CFP. 2212 x 1659 pixels. 45-degree field of view — 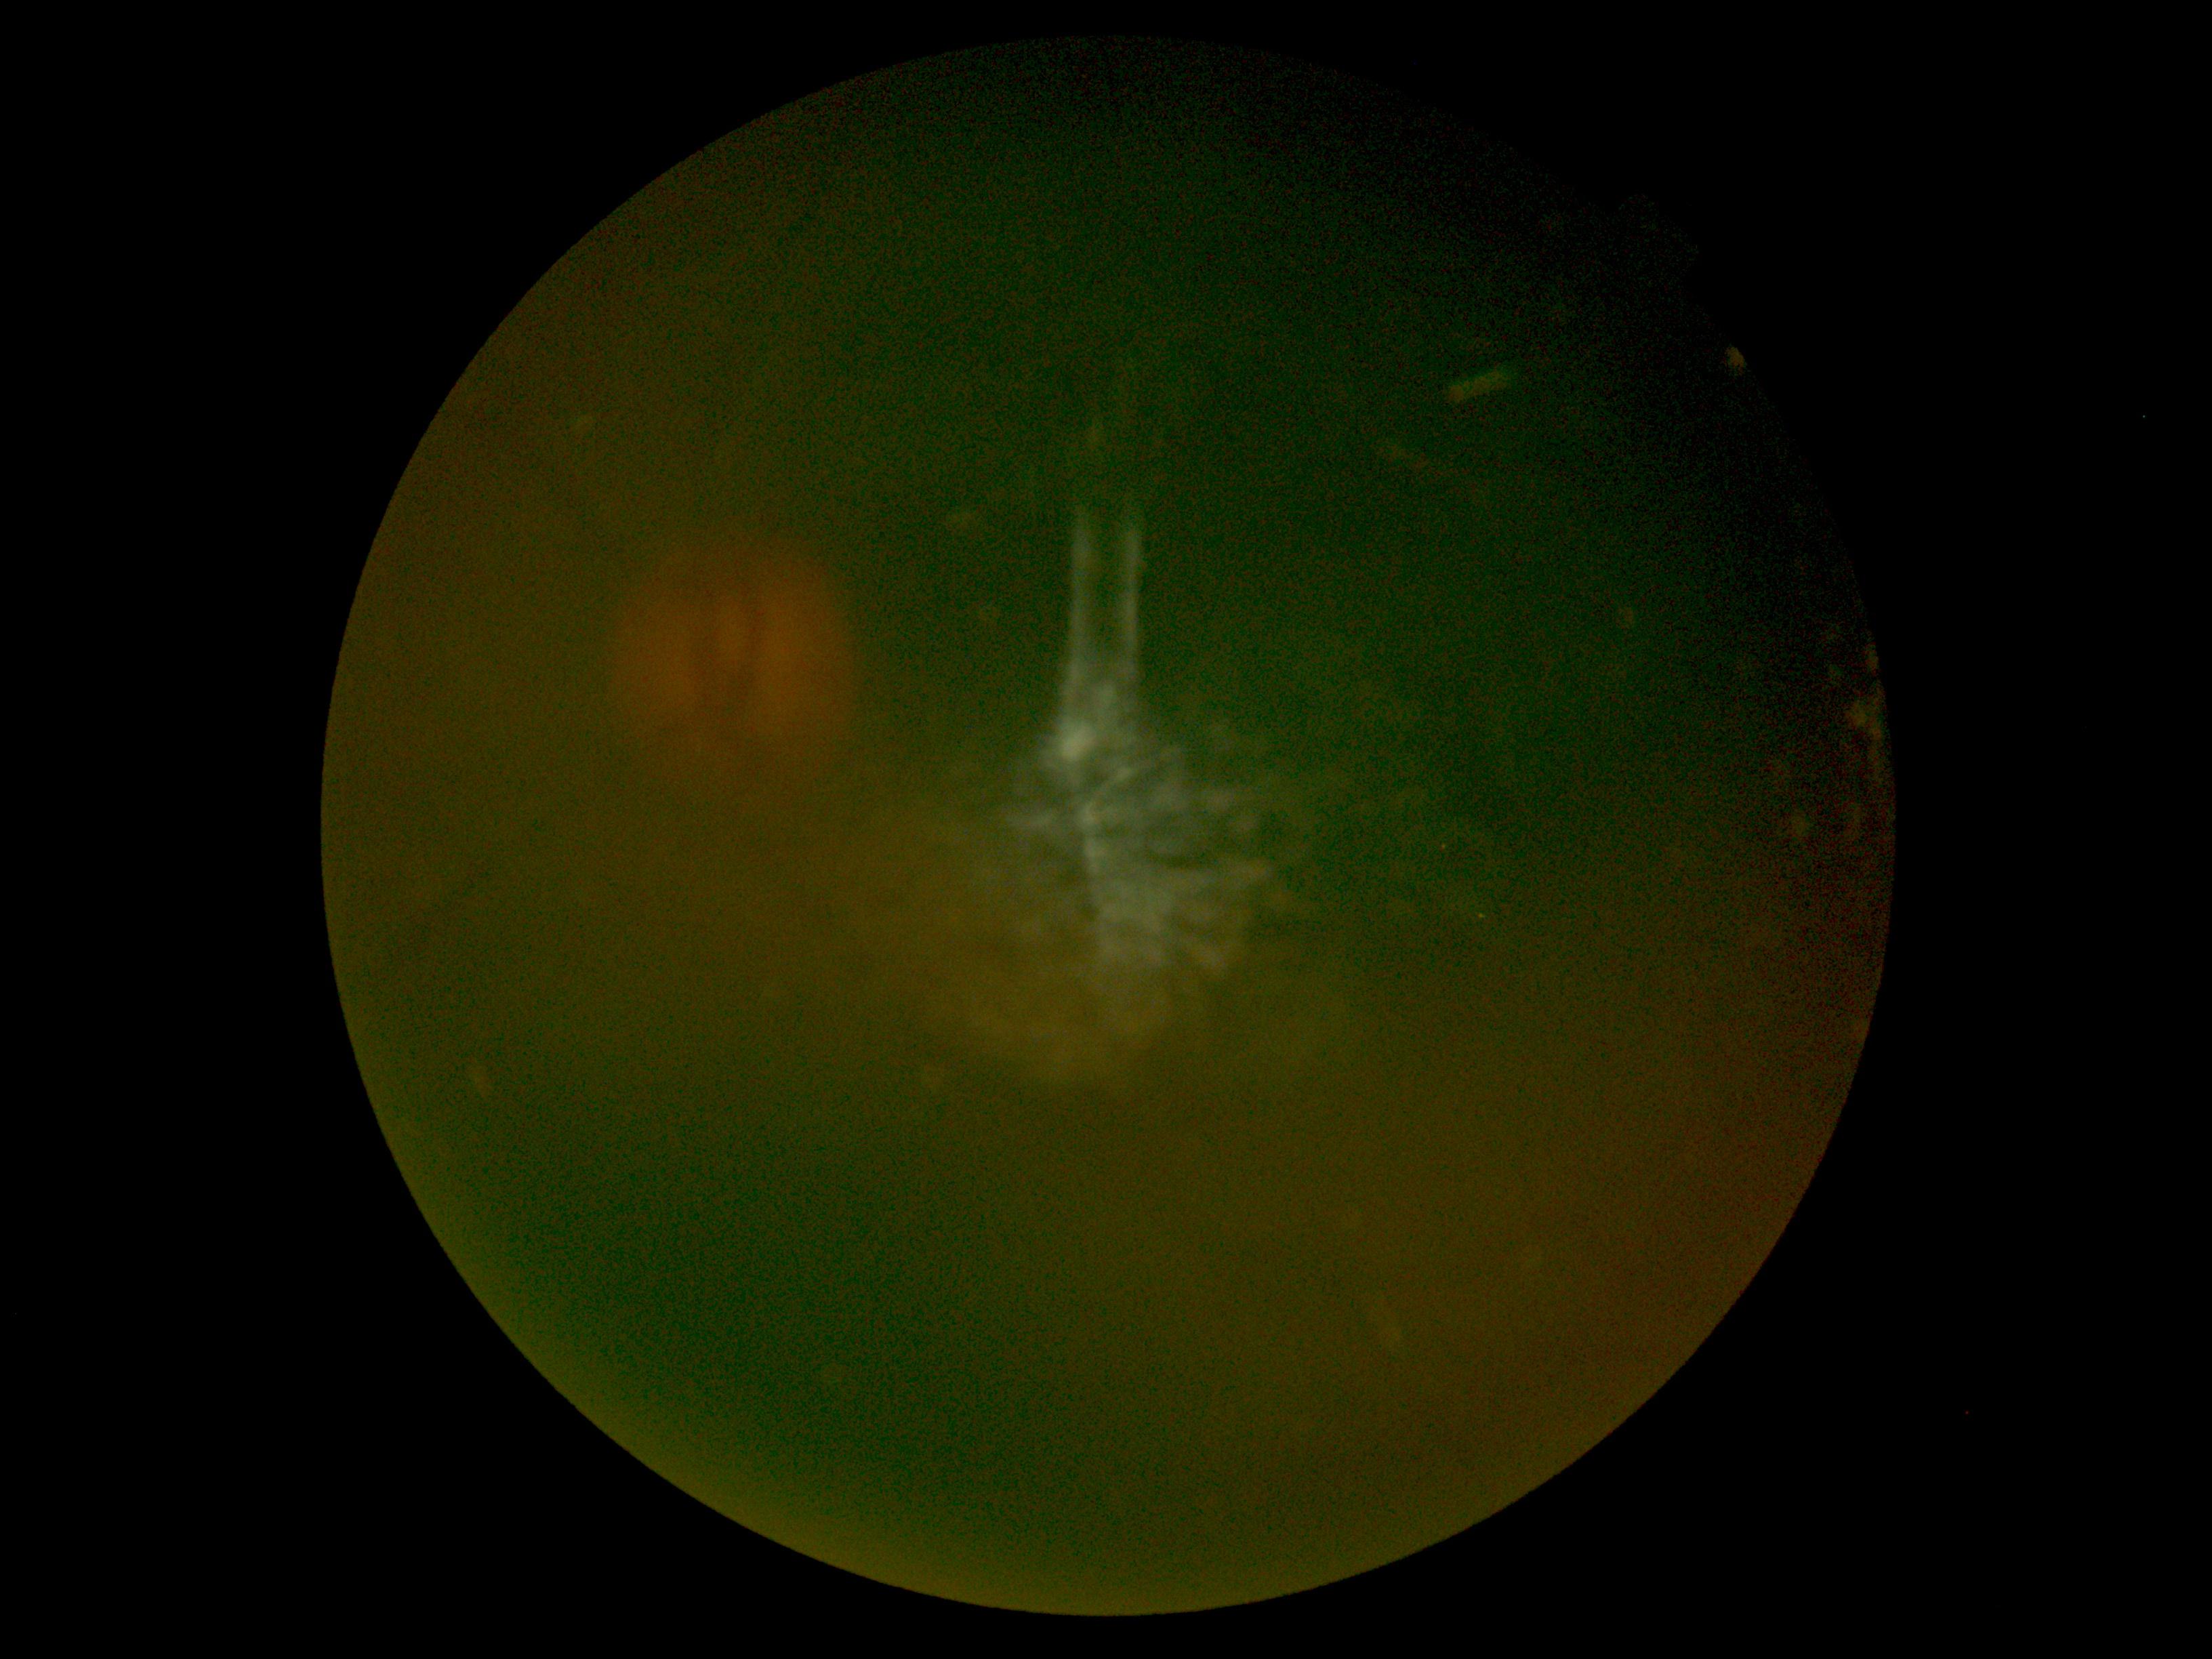 Image quality is insufficient for diabetic retinopathy assessment.
DR grade is ungradable due to poor image quality.